FOV: 50 degrees: 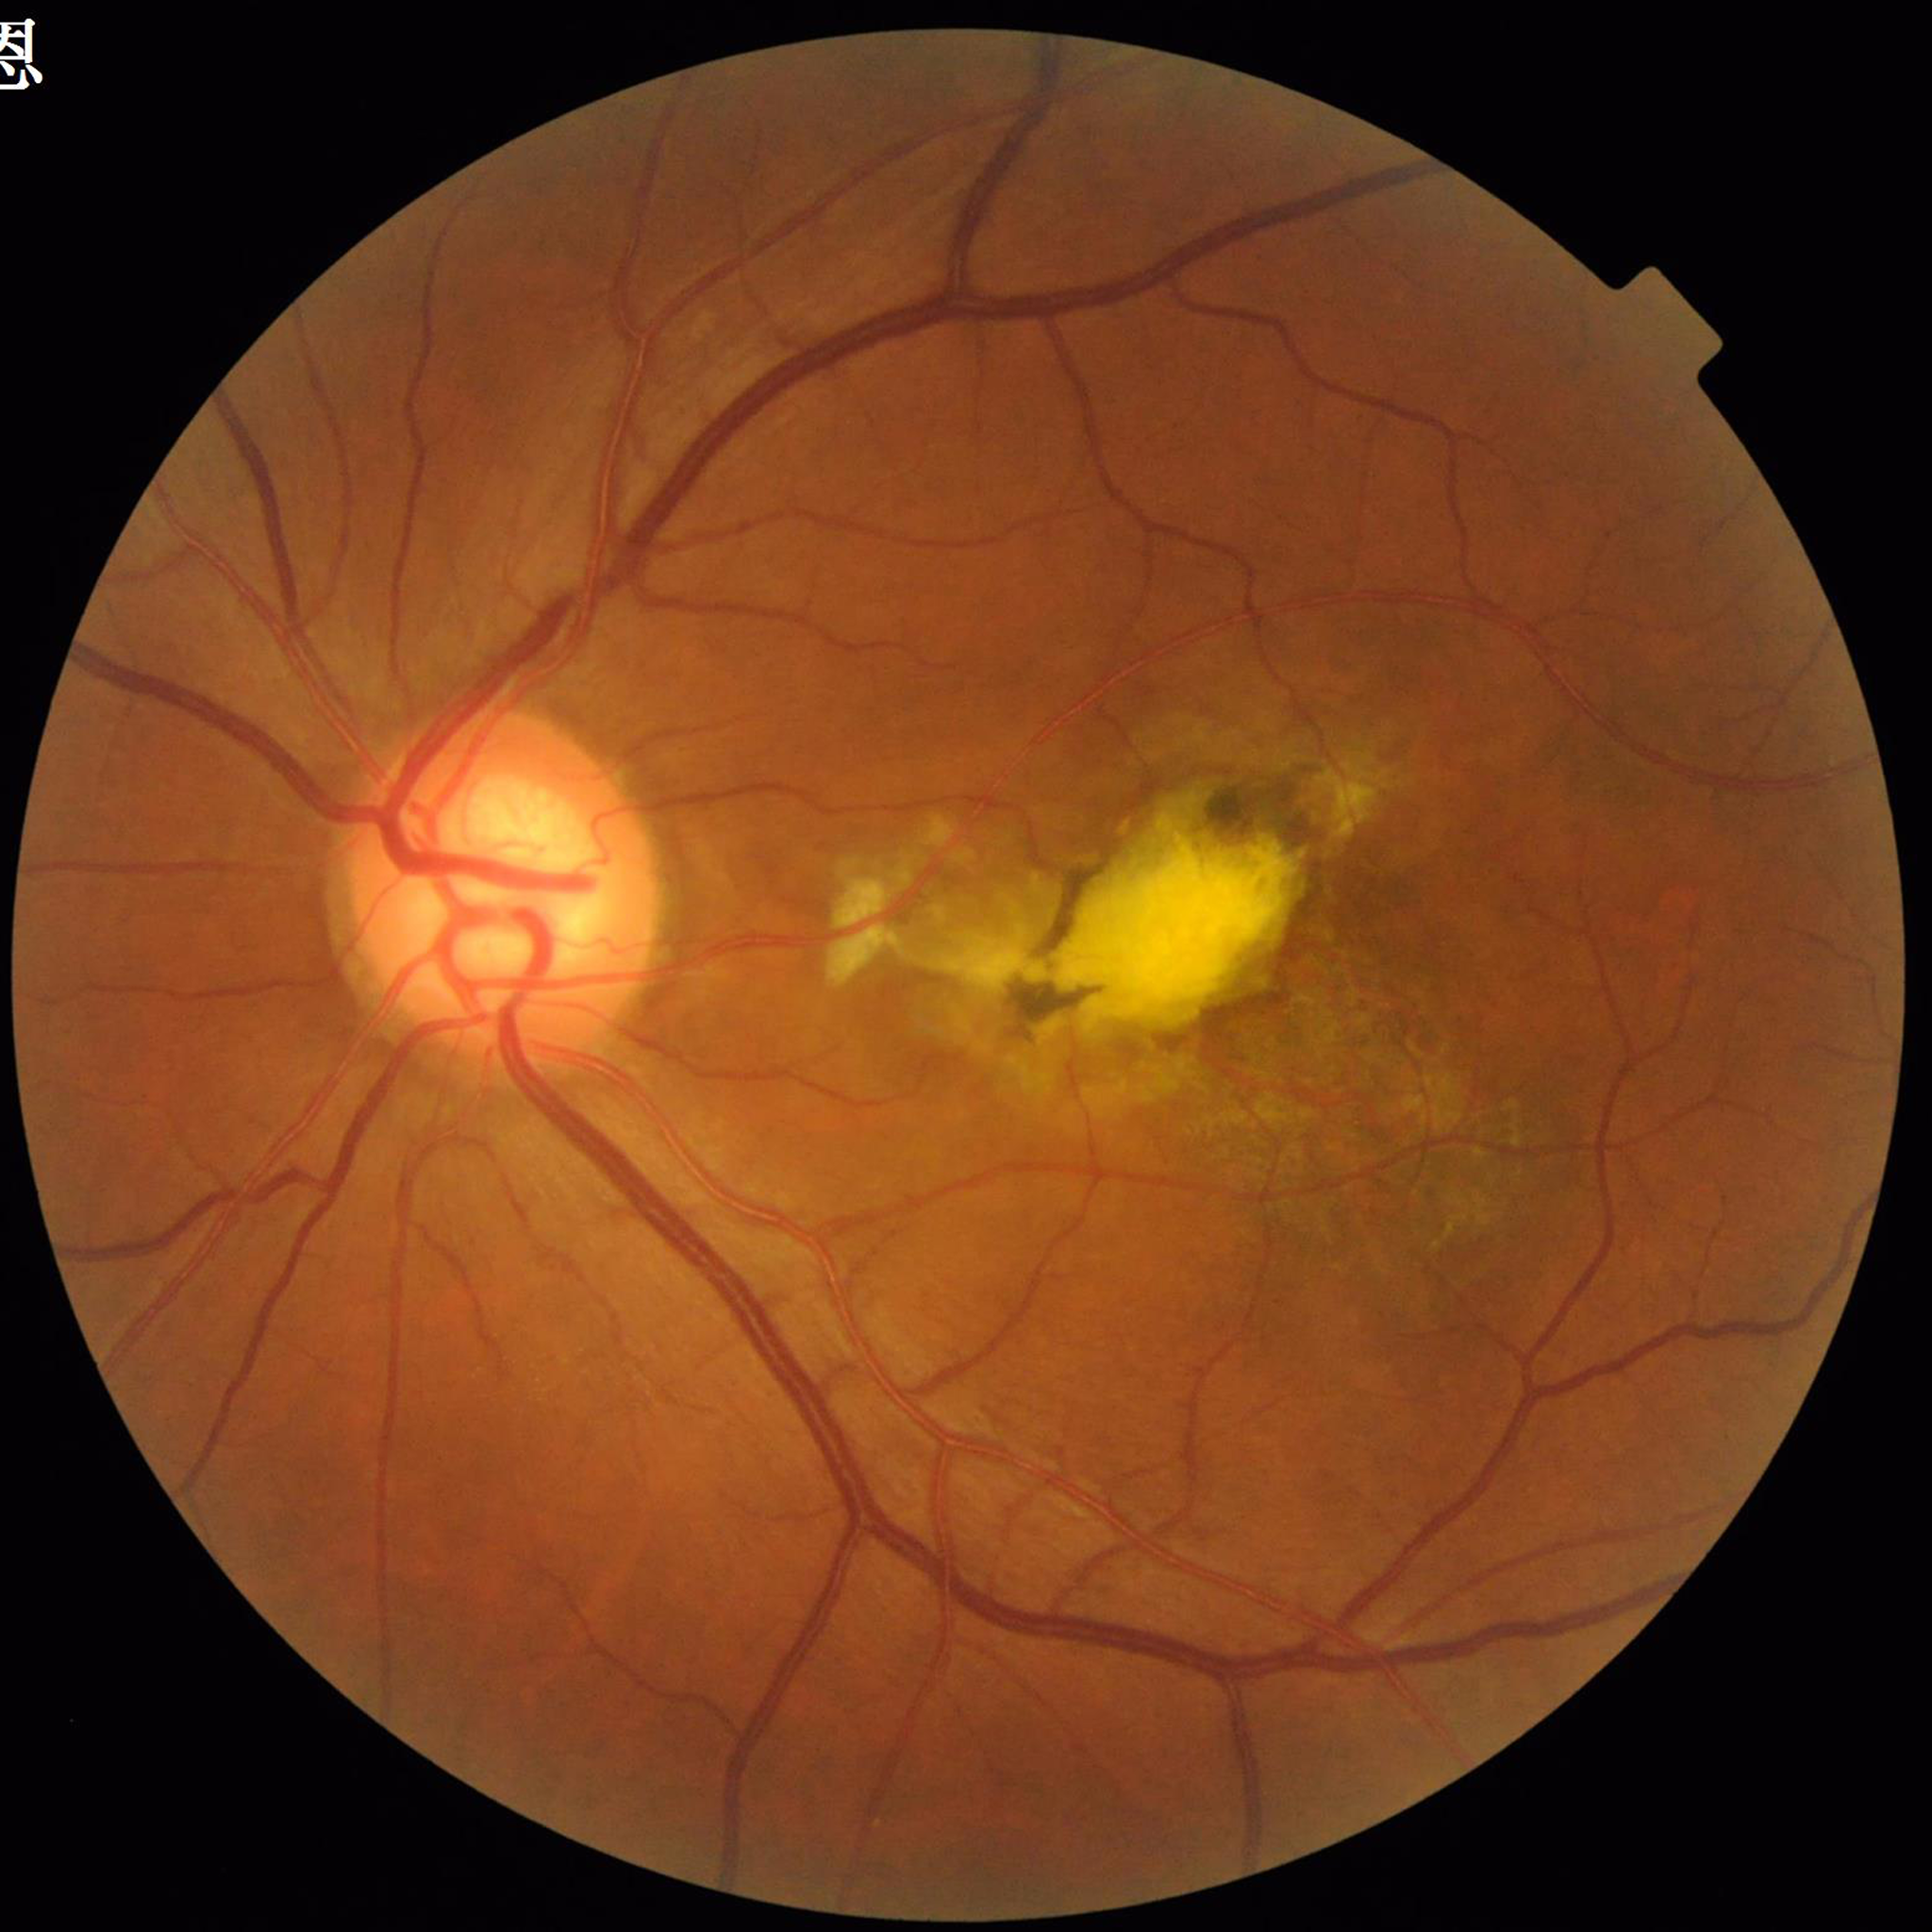

Disease class: age-related macular degeneration.